Fundus photo, no pharmacologic dilation, modified Davis classification, 848x848, FOV: 45 degrees: 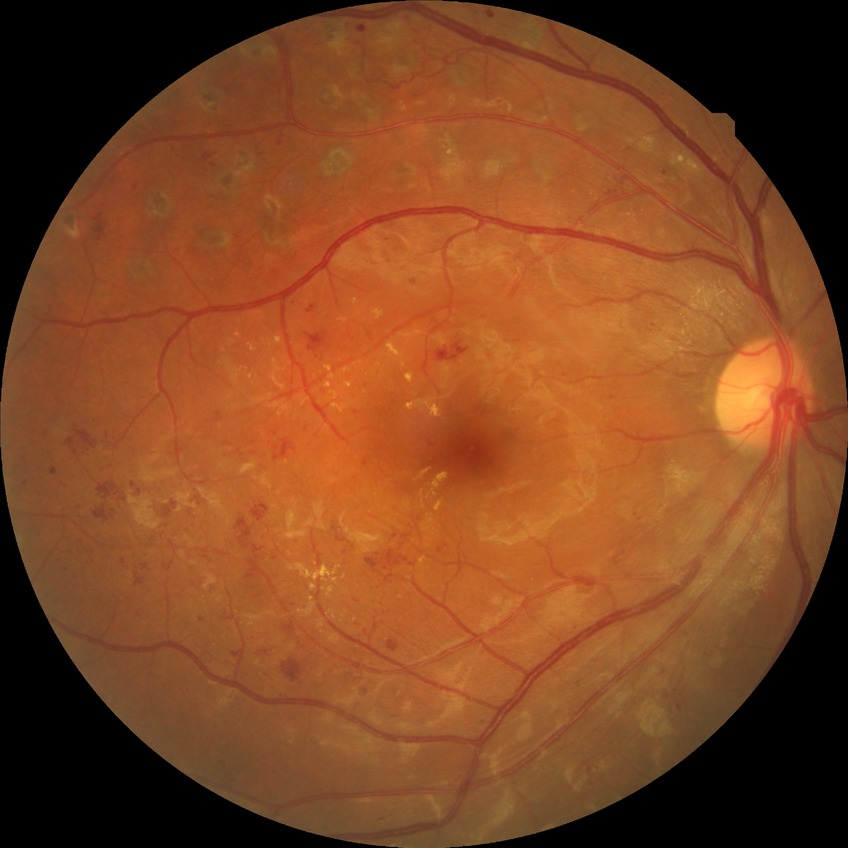 Davis grading: proliferative diabetic retinopathy.